2361x1568px. FOV: 45 degrees.
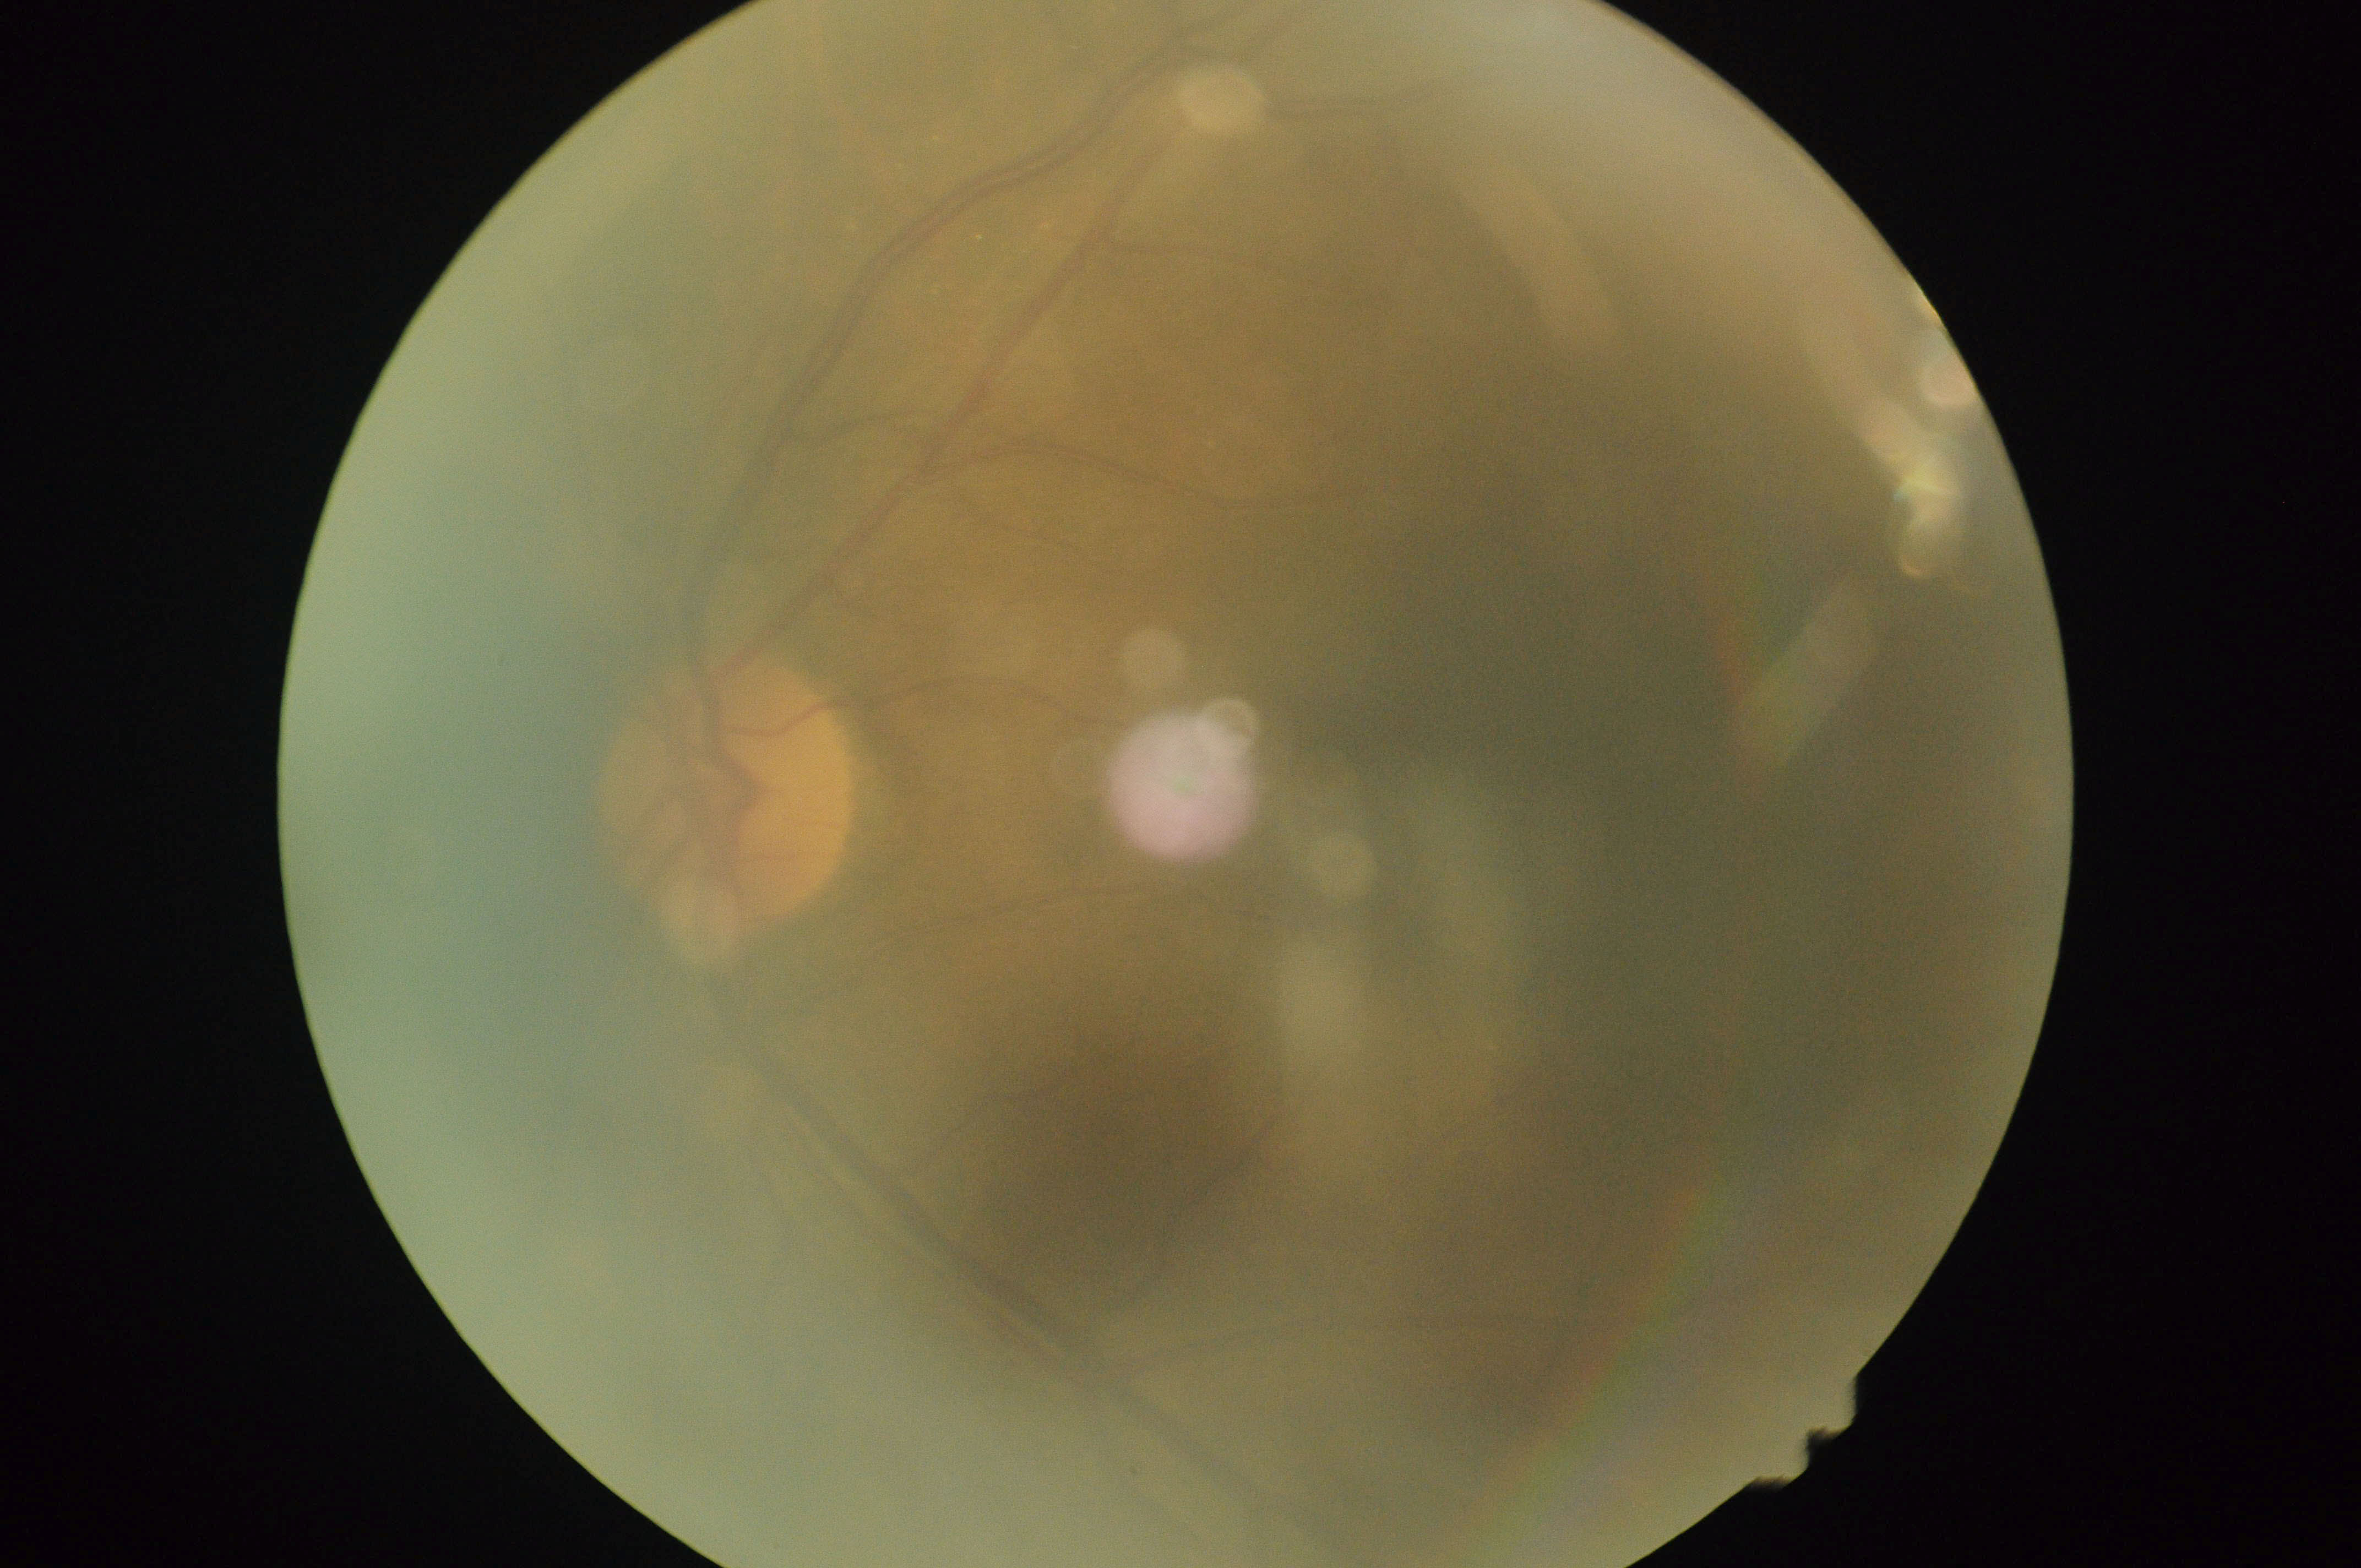 No apparent diabetic retinopathy. DR severity: no apparent retinopathy (grade 0).